Pediatric retinal photograph (wide-field).
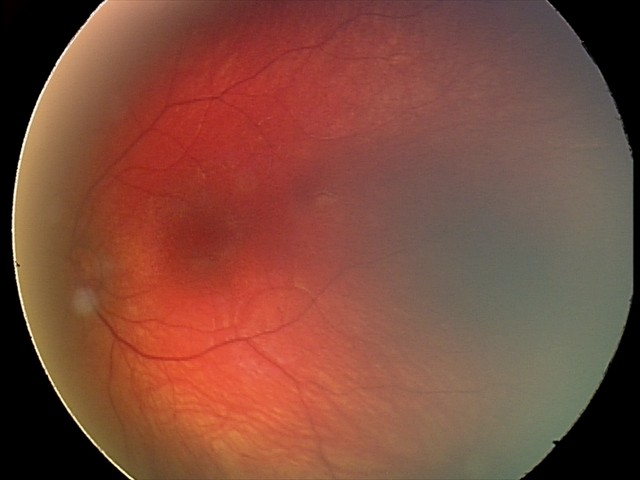

Diagnosis: retinal hemorrhages.